Davis DR grading, 848 by 848 pixels
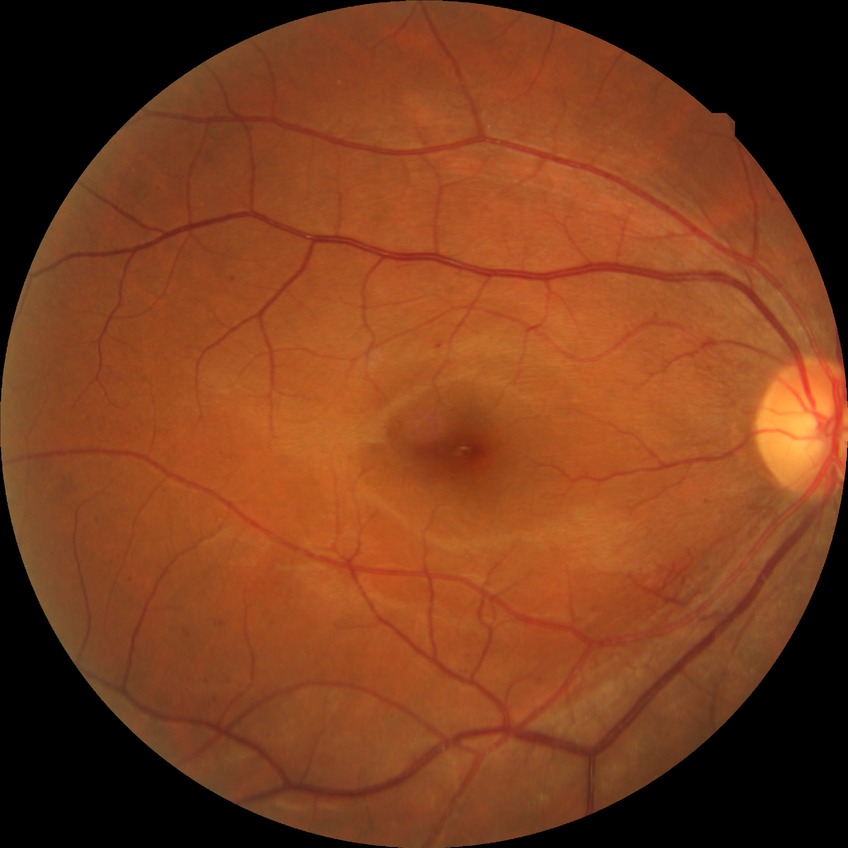

Diabetic retinopathy (DR) is SDR (simple diabetic retinopathy). The retinopathy is classified as non-proliferative diabetic retinopathy.